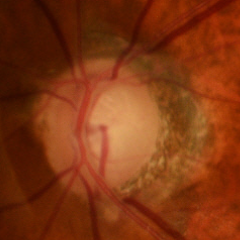
Glaucoma assessment = early glaucomatous changes.